Captured after pupil dilation · FOV: 50 degrees · posterior pole view: 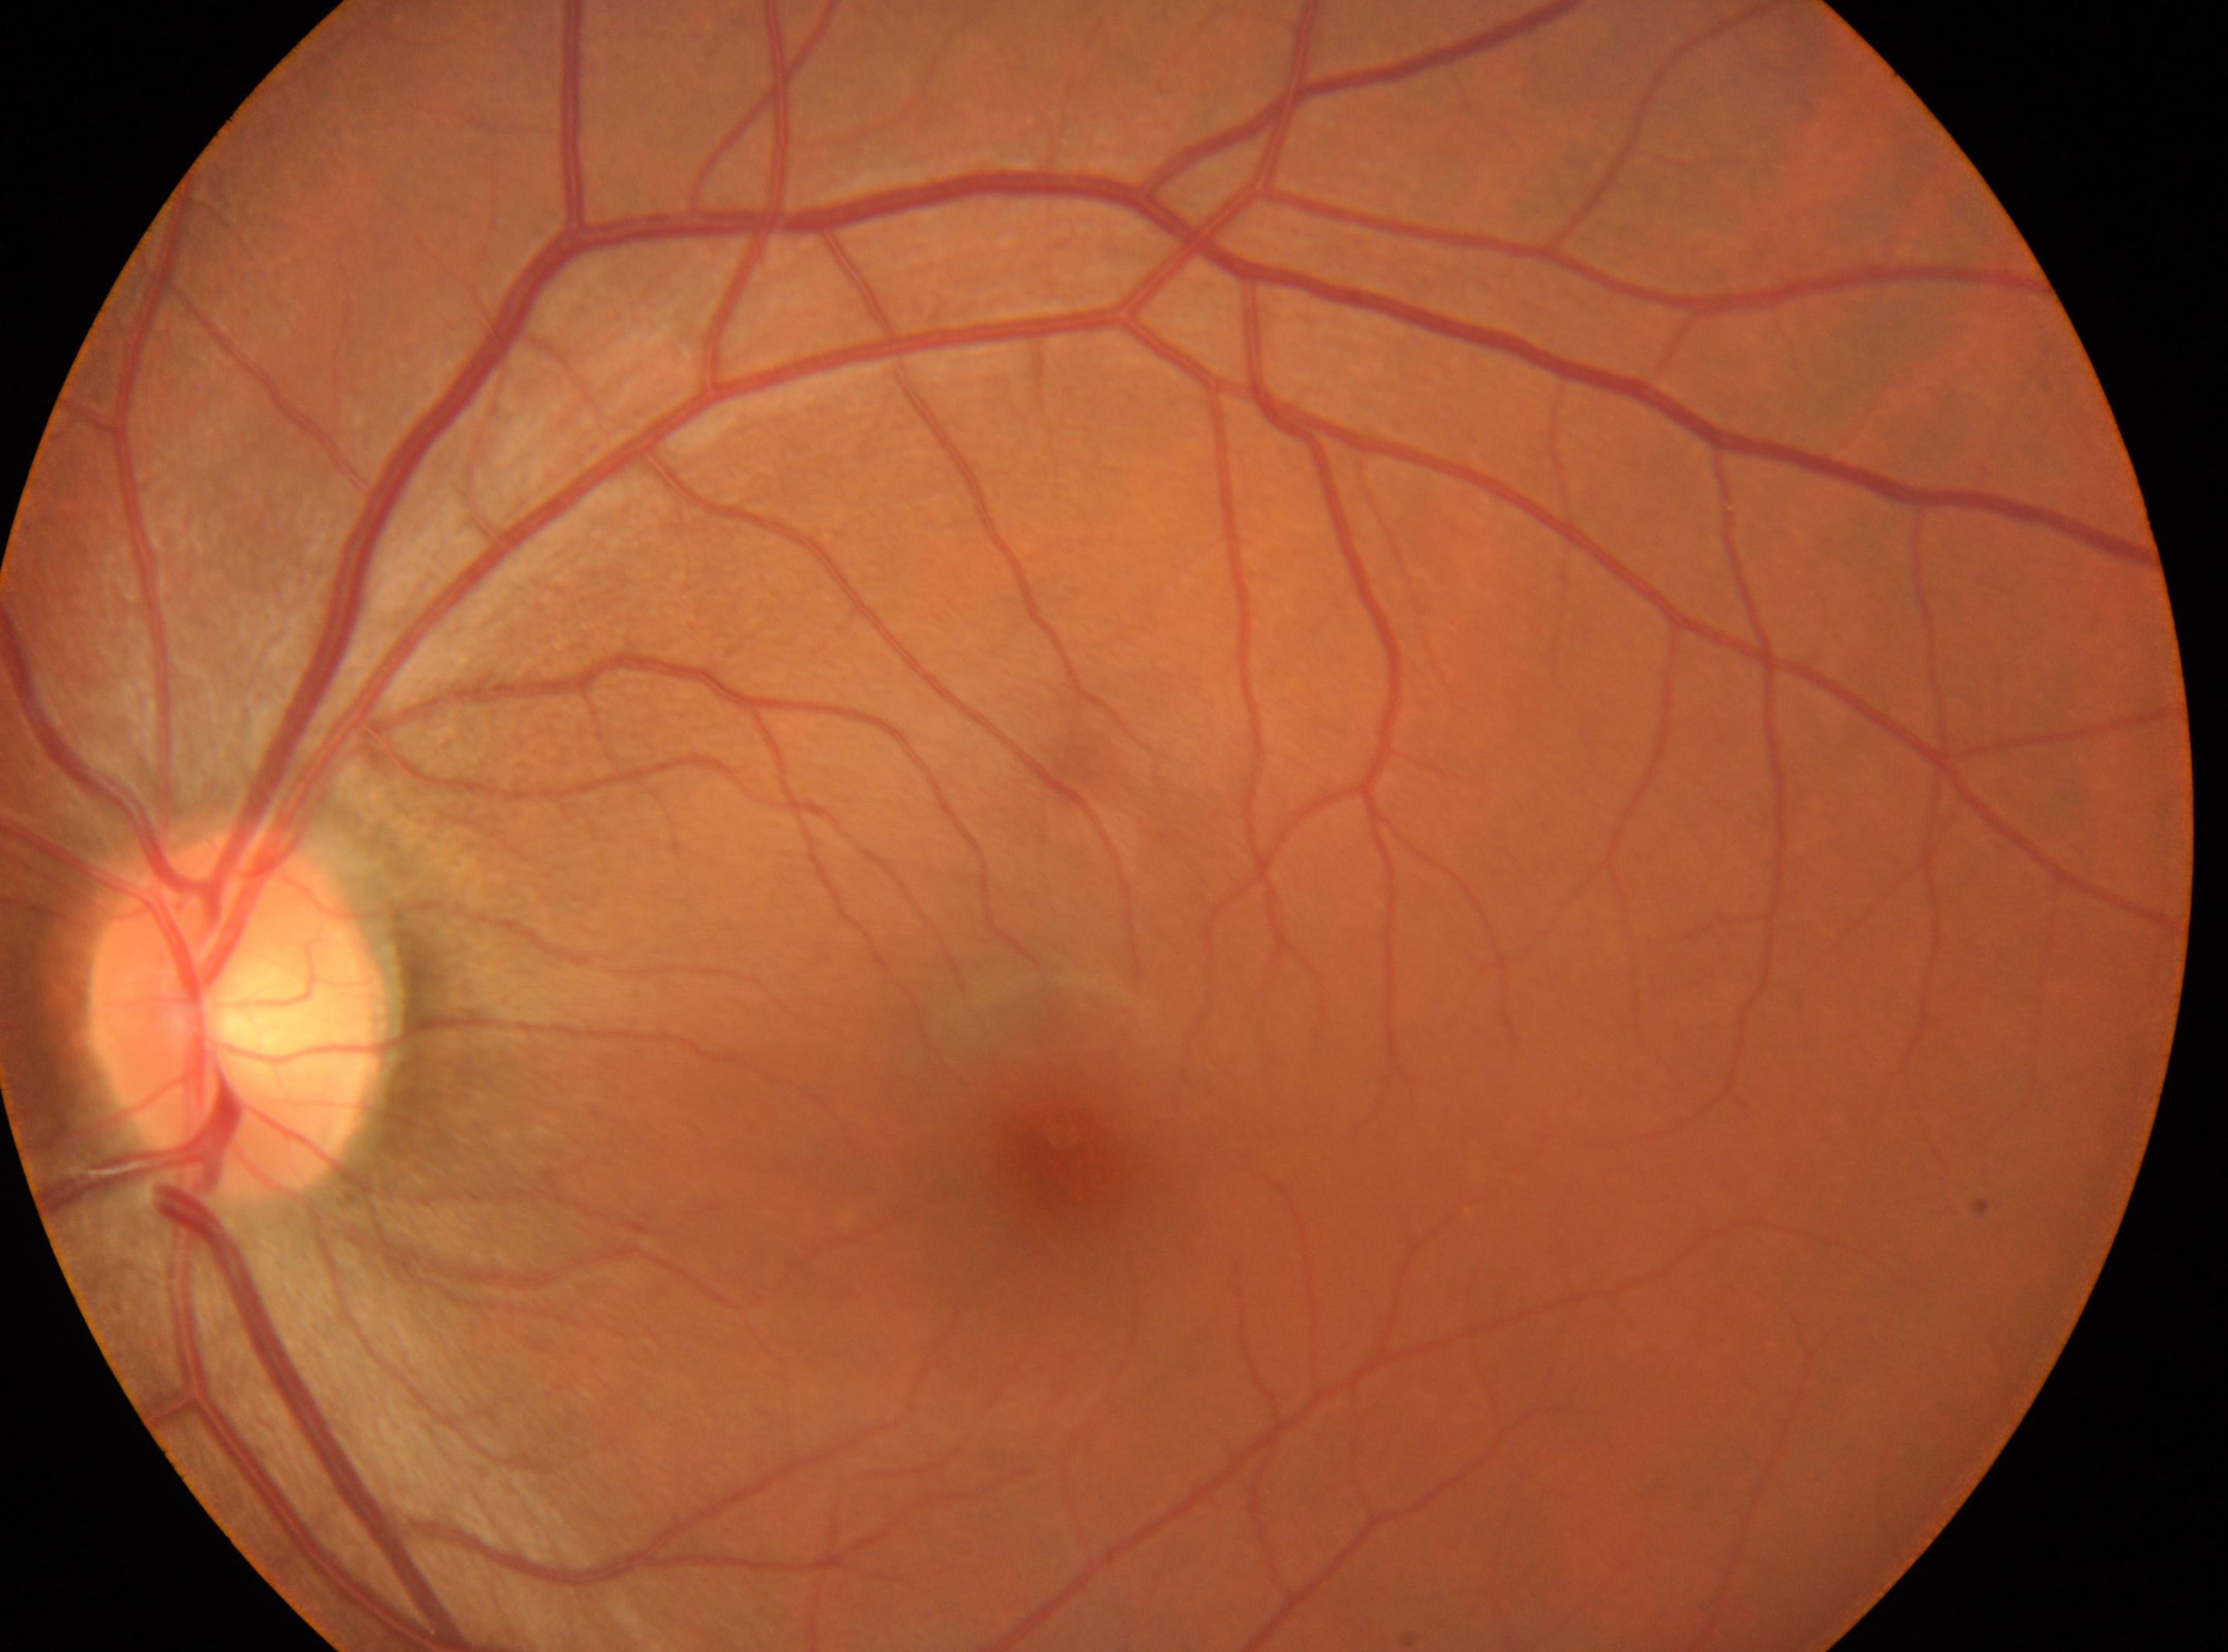

fovea = 1074, 1165 | DR impression = No diabetic retinal disease findings | eye = OS | optic disc = 237, 1013 | retinopathy = 0/4.